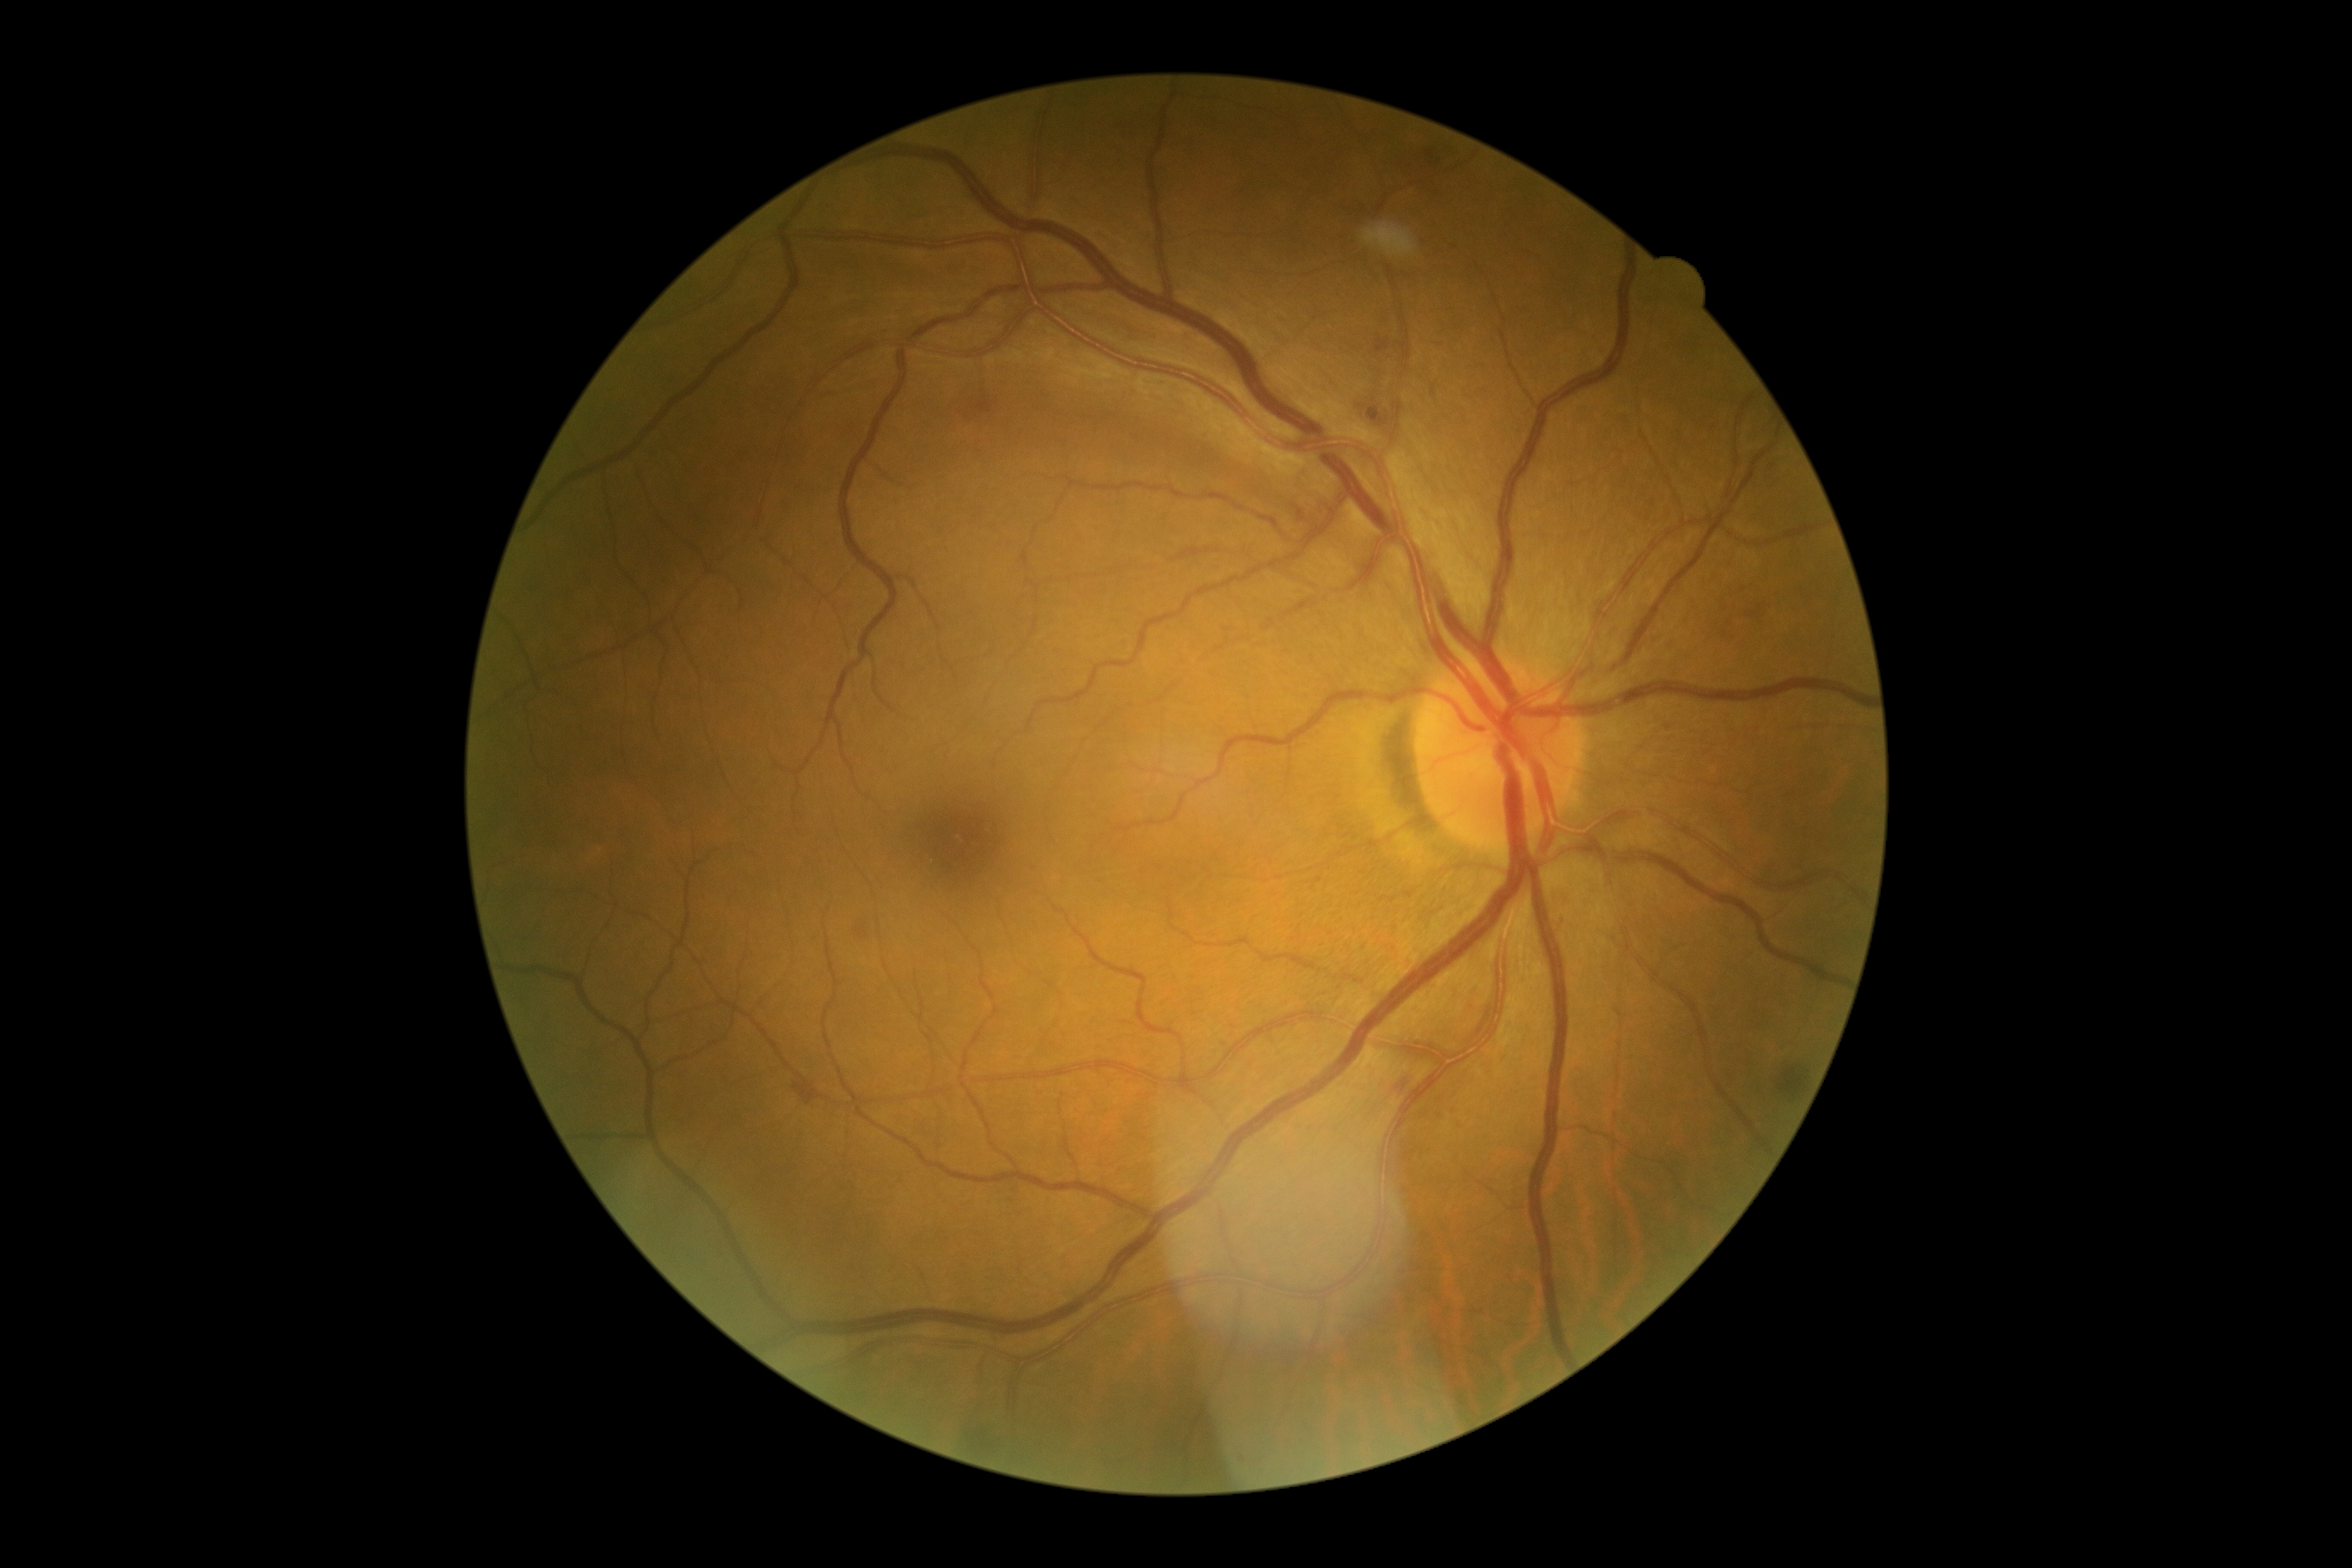 Retinopathy grade: 2 (moderate NPDR).